Nonmydriatic fundus photograph
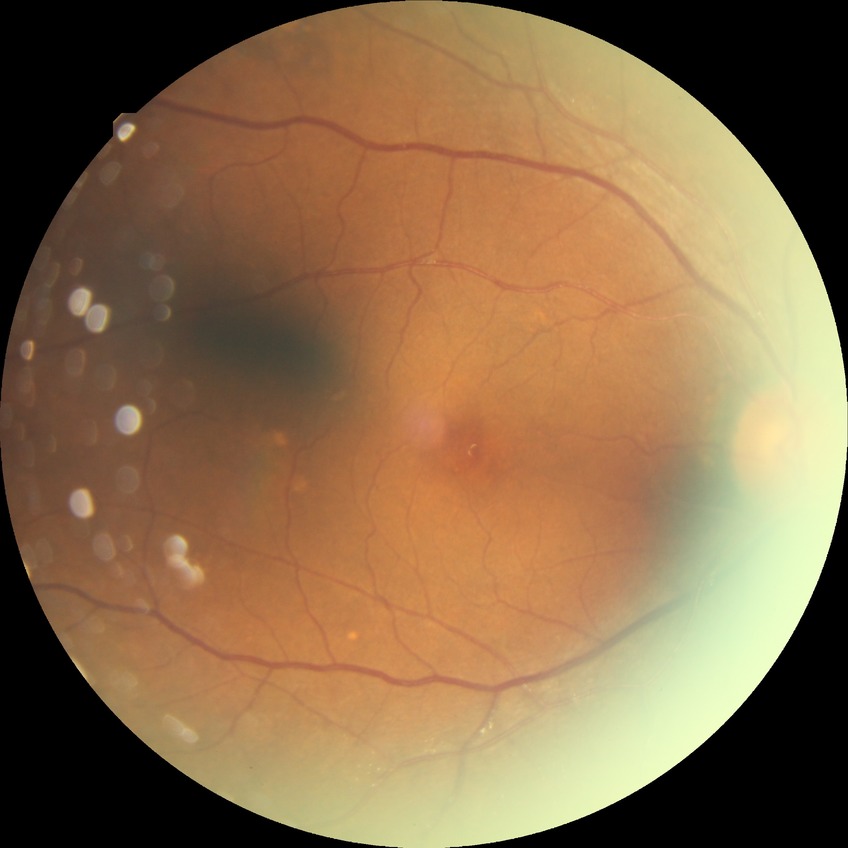 Disease class: non-proliferative diabetic retinopathy.
Davis stage is SDR.